2352 x 1568 pixels.
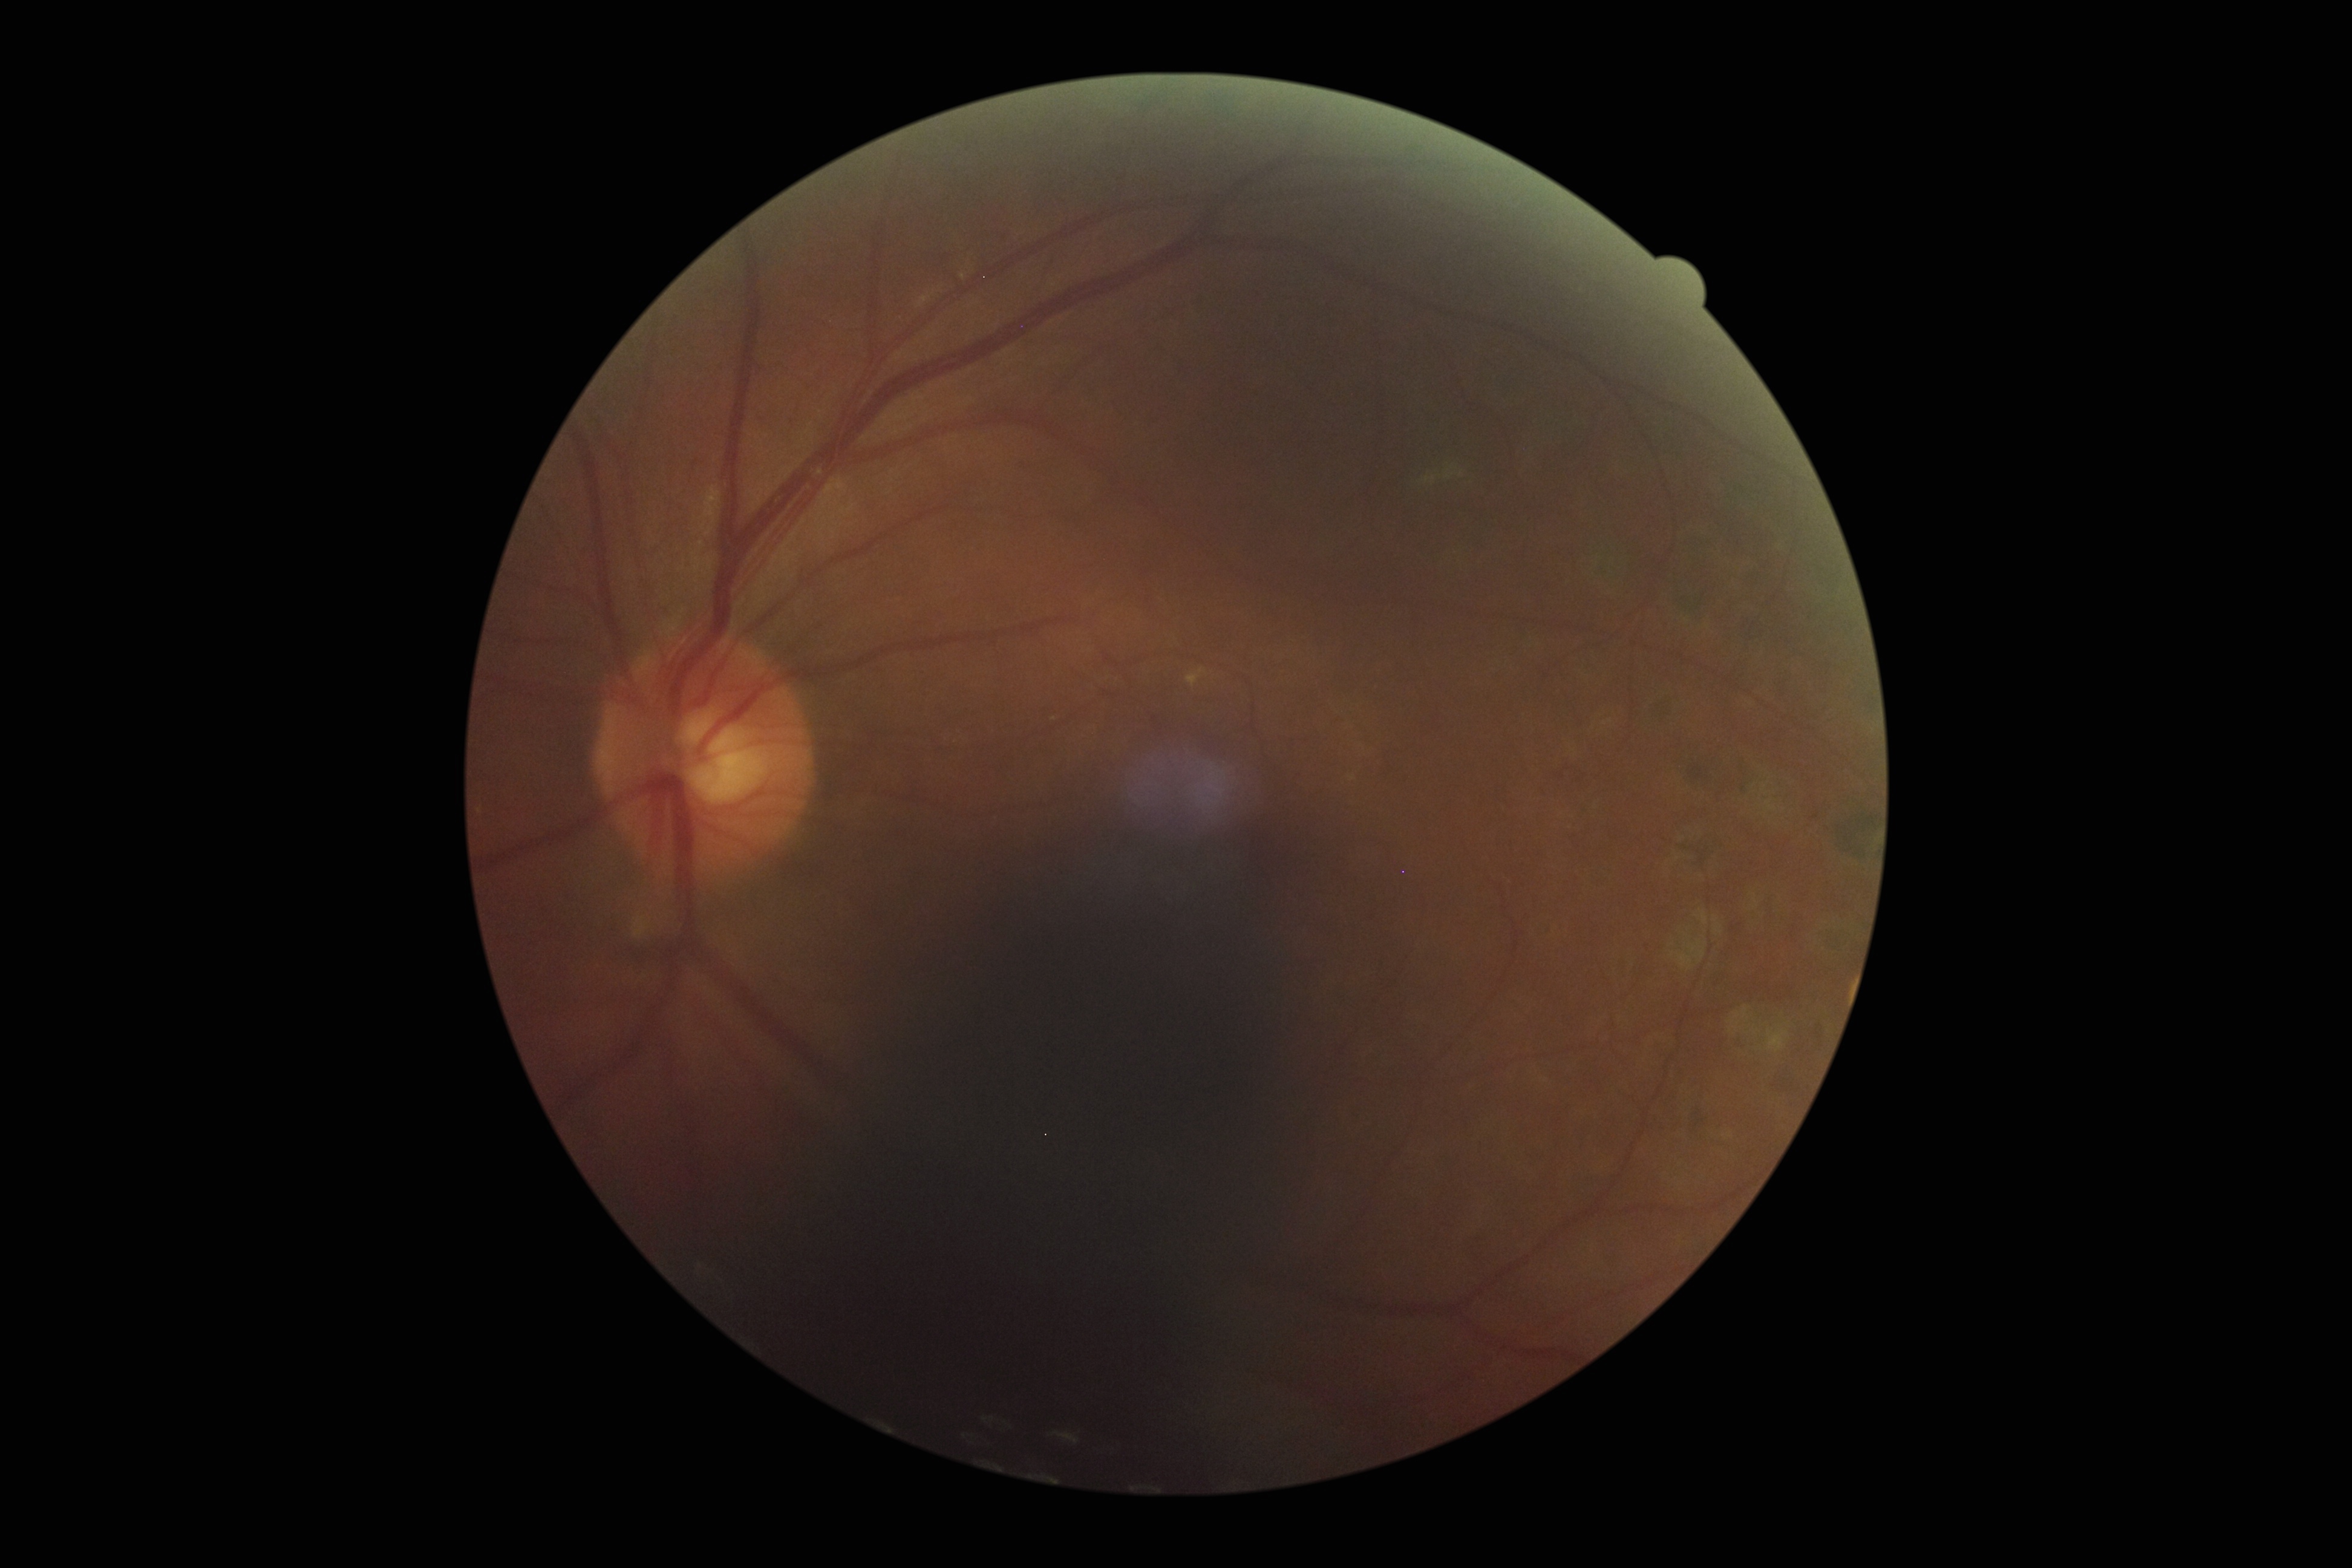
Annotations:
- DR grade: moderate NPDR (2)